FOV: 45 degrees, 848 x 848 pixels: 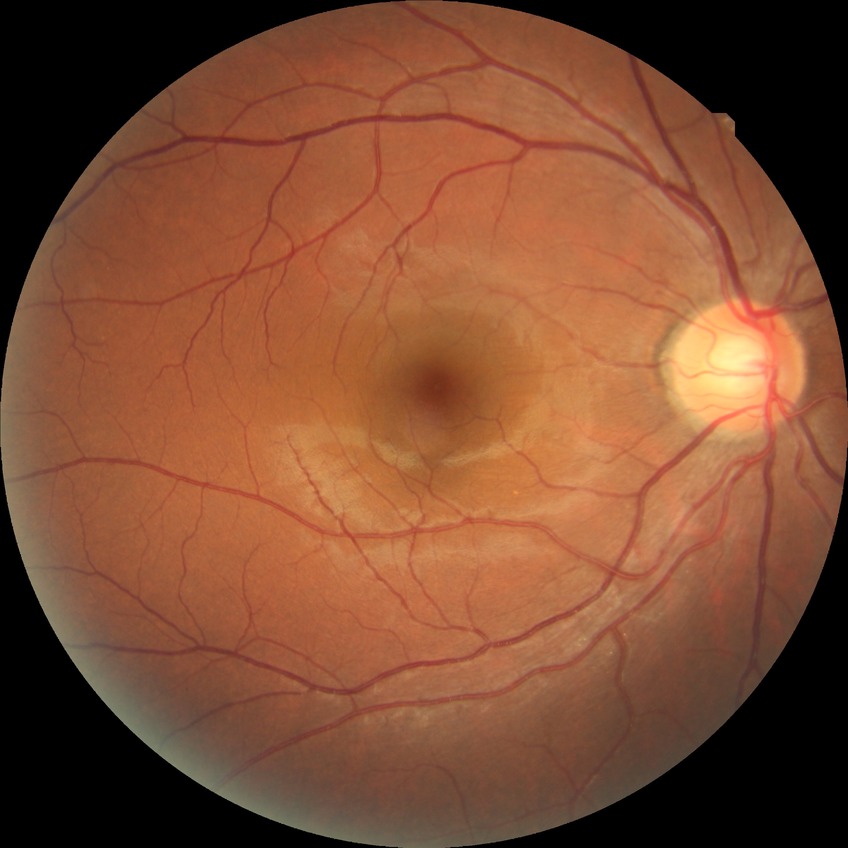

Diabetic retinopathy (DR): NDR (no diabetic retinopathy).